45° FOV. 2352x1568px — 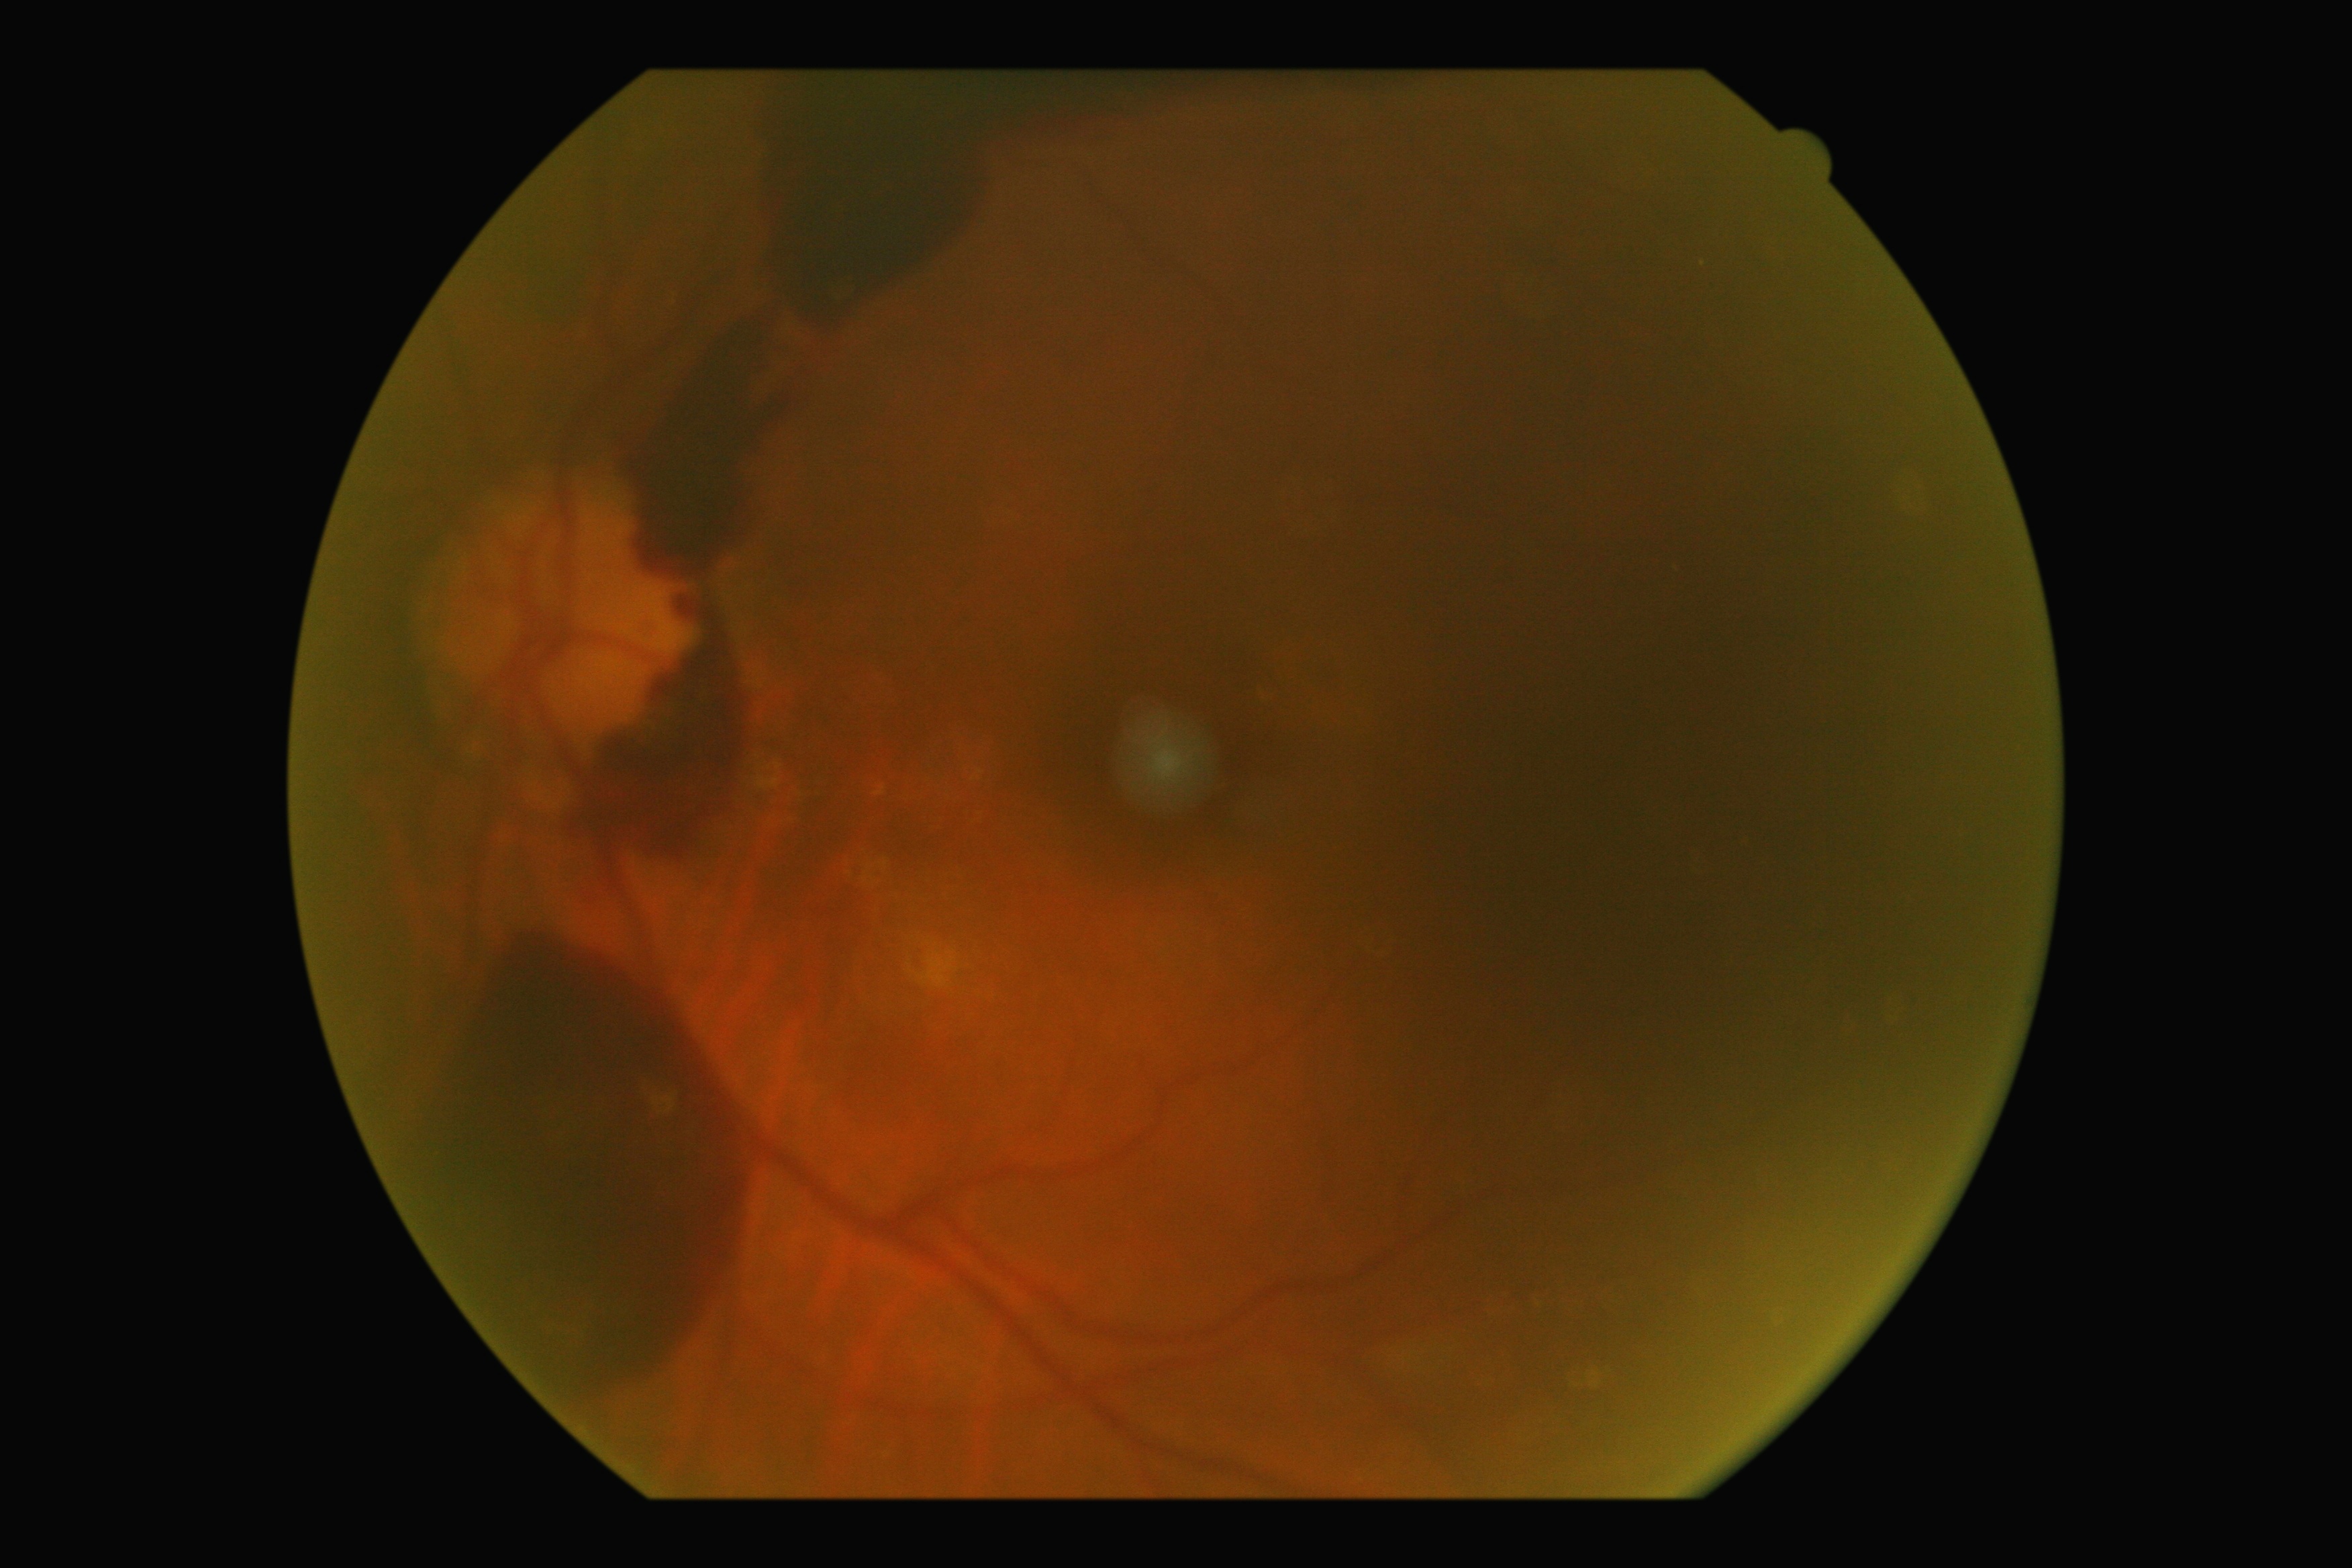

DR class: proliferative diabetic retinopathy. Diabetic retinopathy severity is proliferative diabetic retinopathy (grade 4) — neovascularization and/or vitreous/pre-retinal hemorrhage.